Ultra-widefield fundus photograph · 1924 by 1556 pixels — 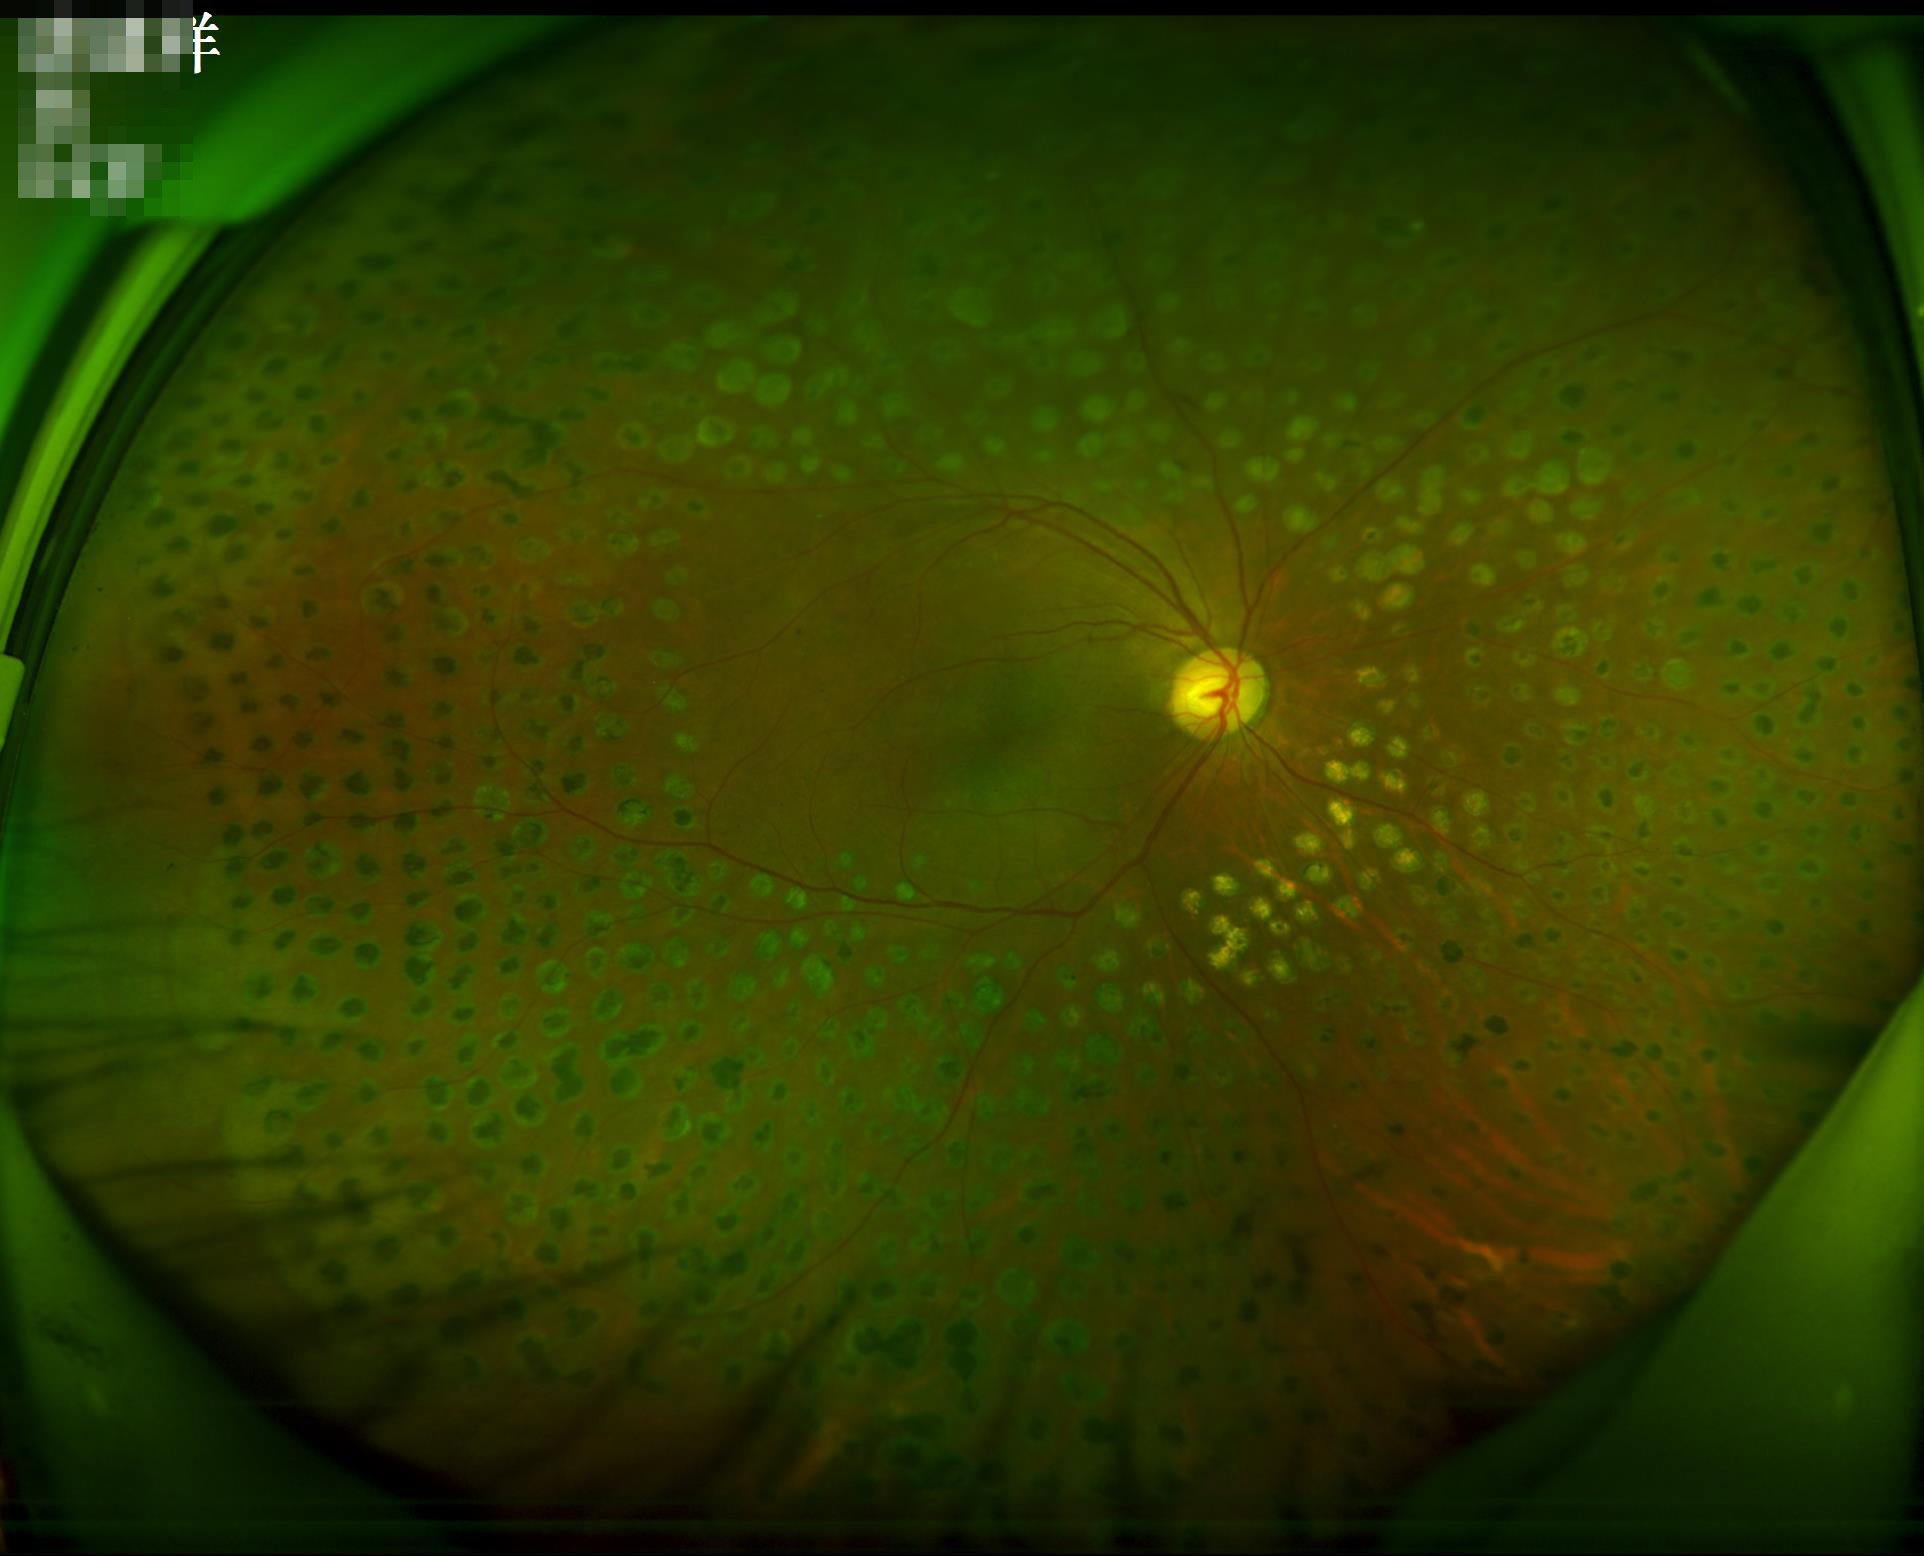

Illumination is even. Contrast is good. Overall quality is good and the image is gradable. The image is clear.